50-degree field of view. Mydriatic (tropicamide and phenylephrine).
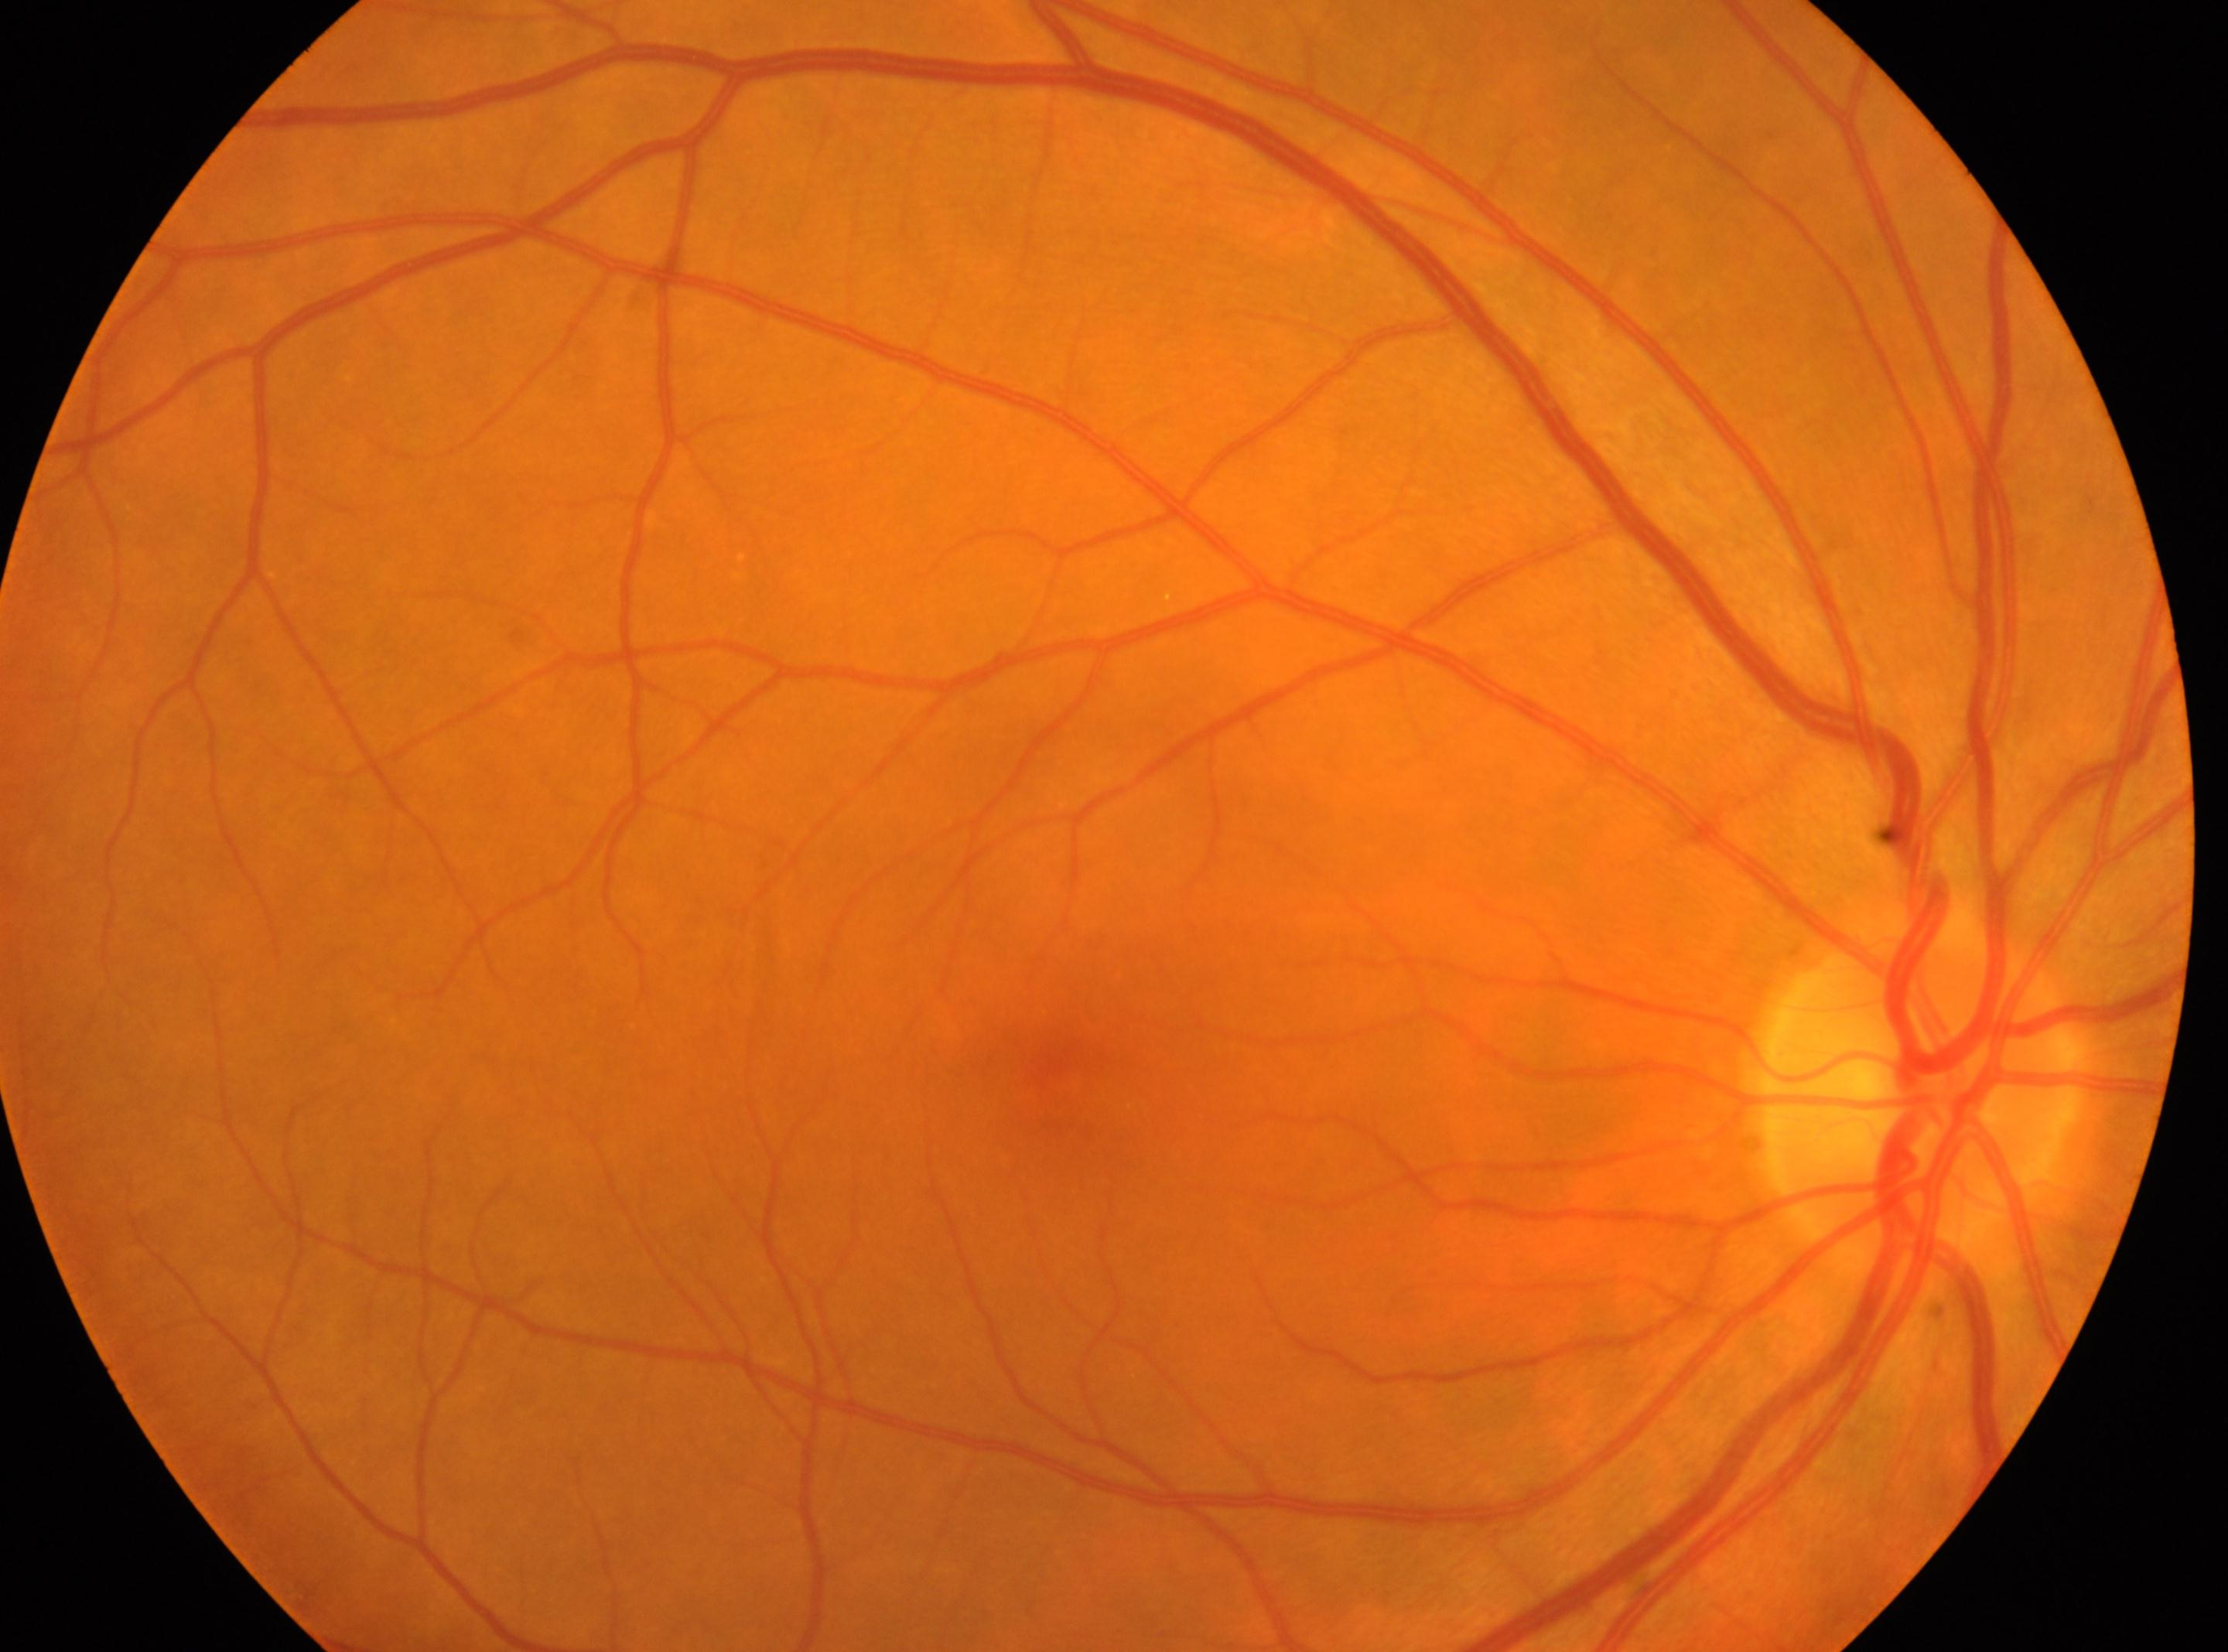 The fovea centralis is at x=1055, y=1069.
DR severity is no apparent retinopathy (grade 0).
Imaged eye: oculus dexter.
Disc center: x=1921, y=1086.